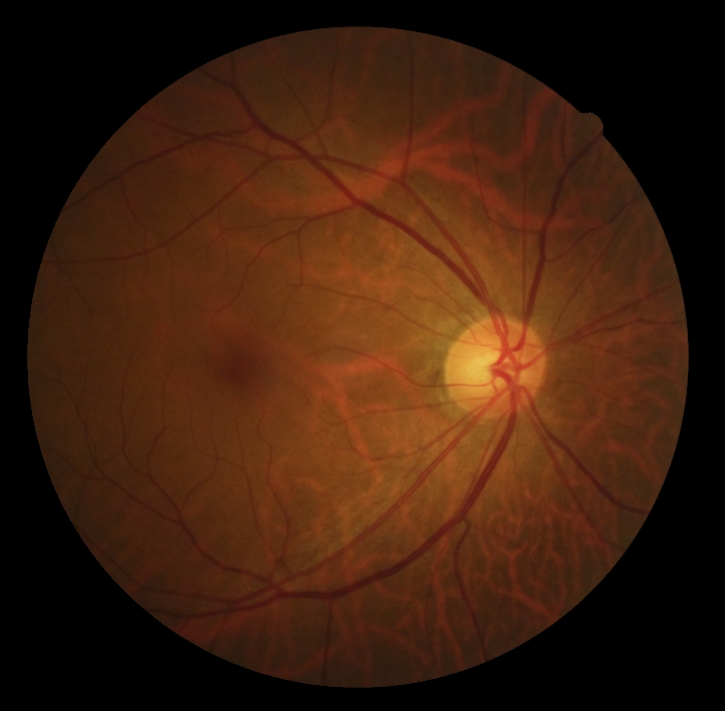
Findings:
– DR severity: 0/4